CFP: 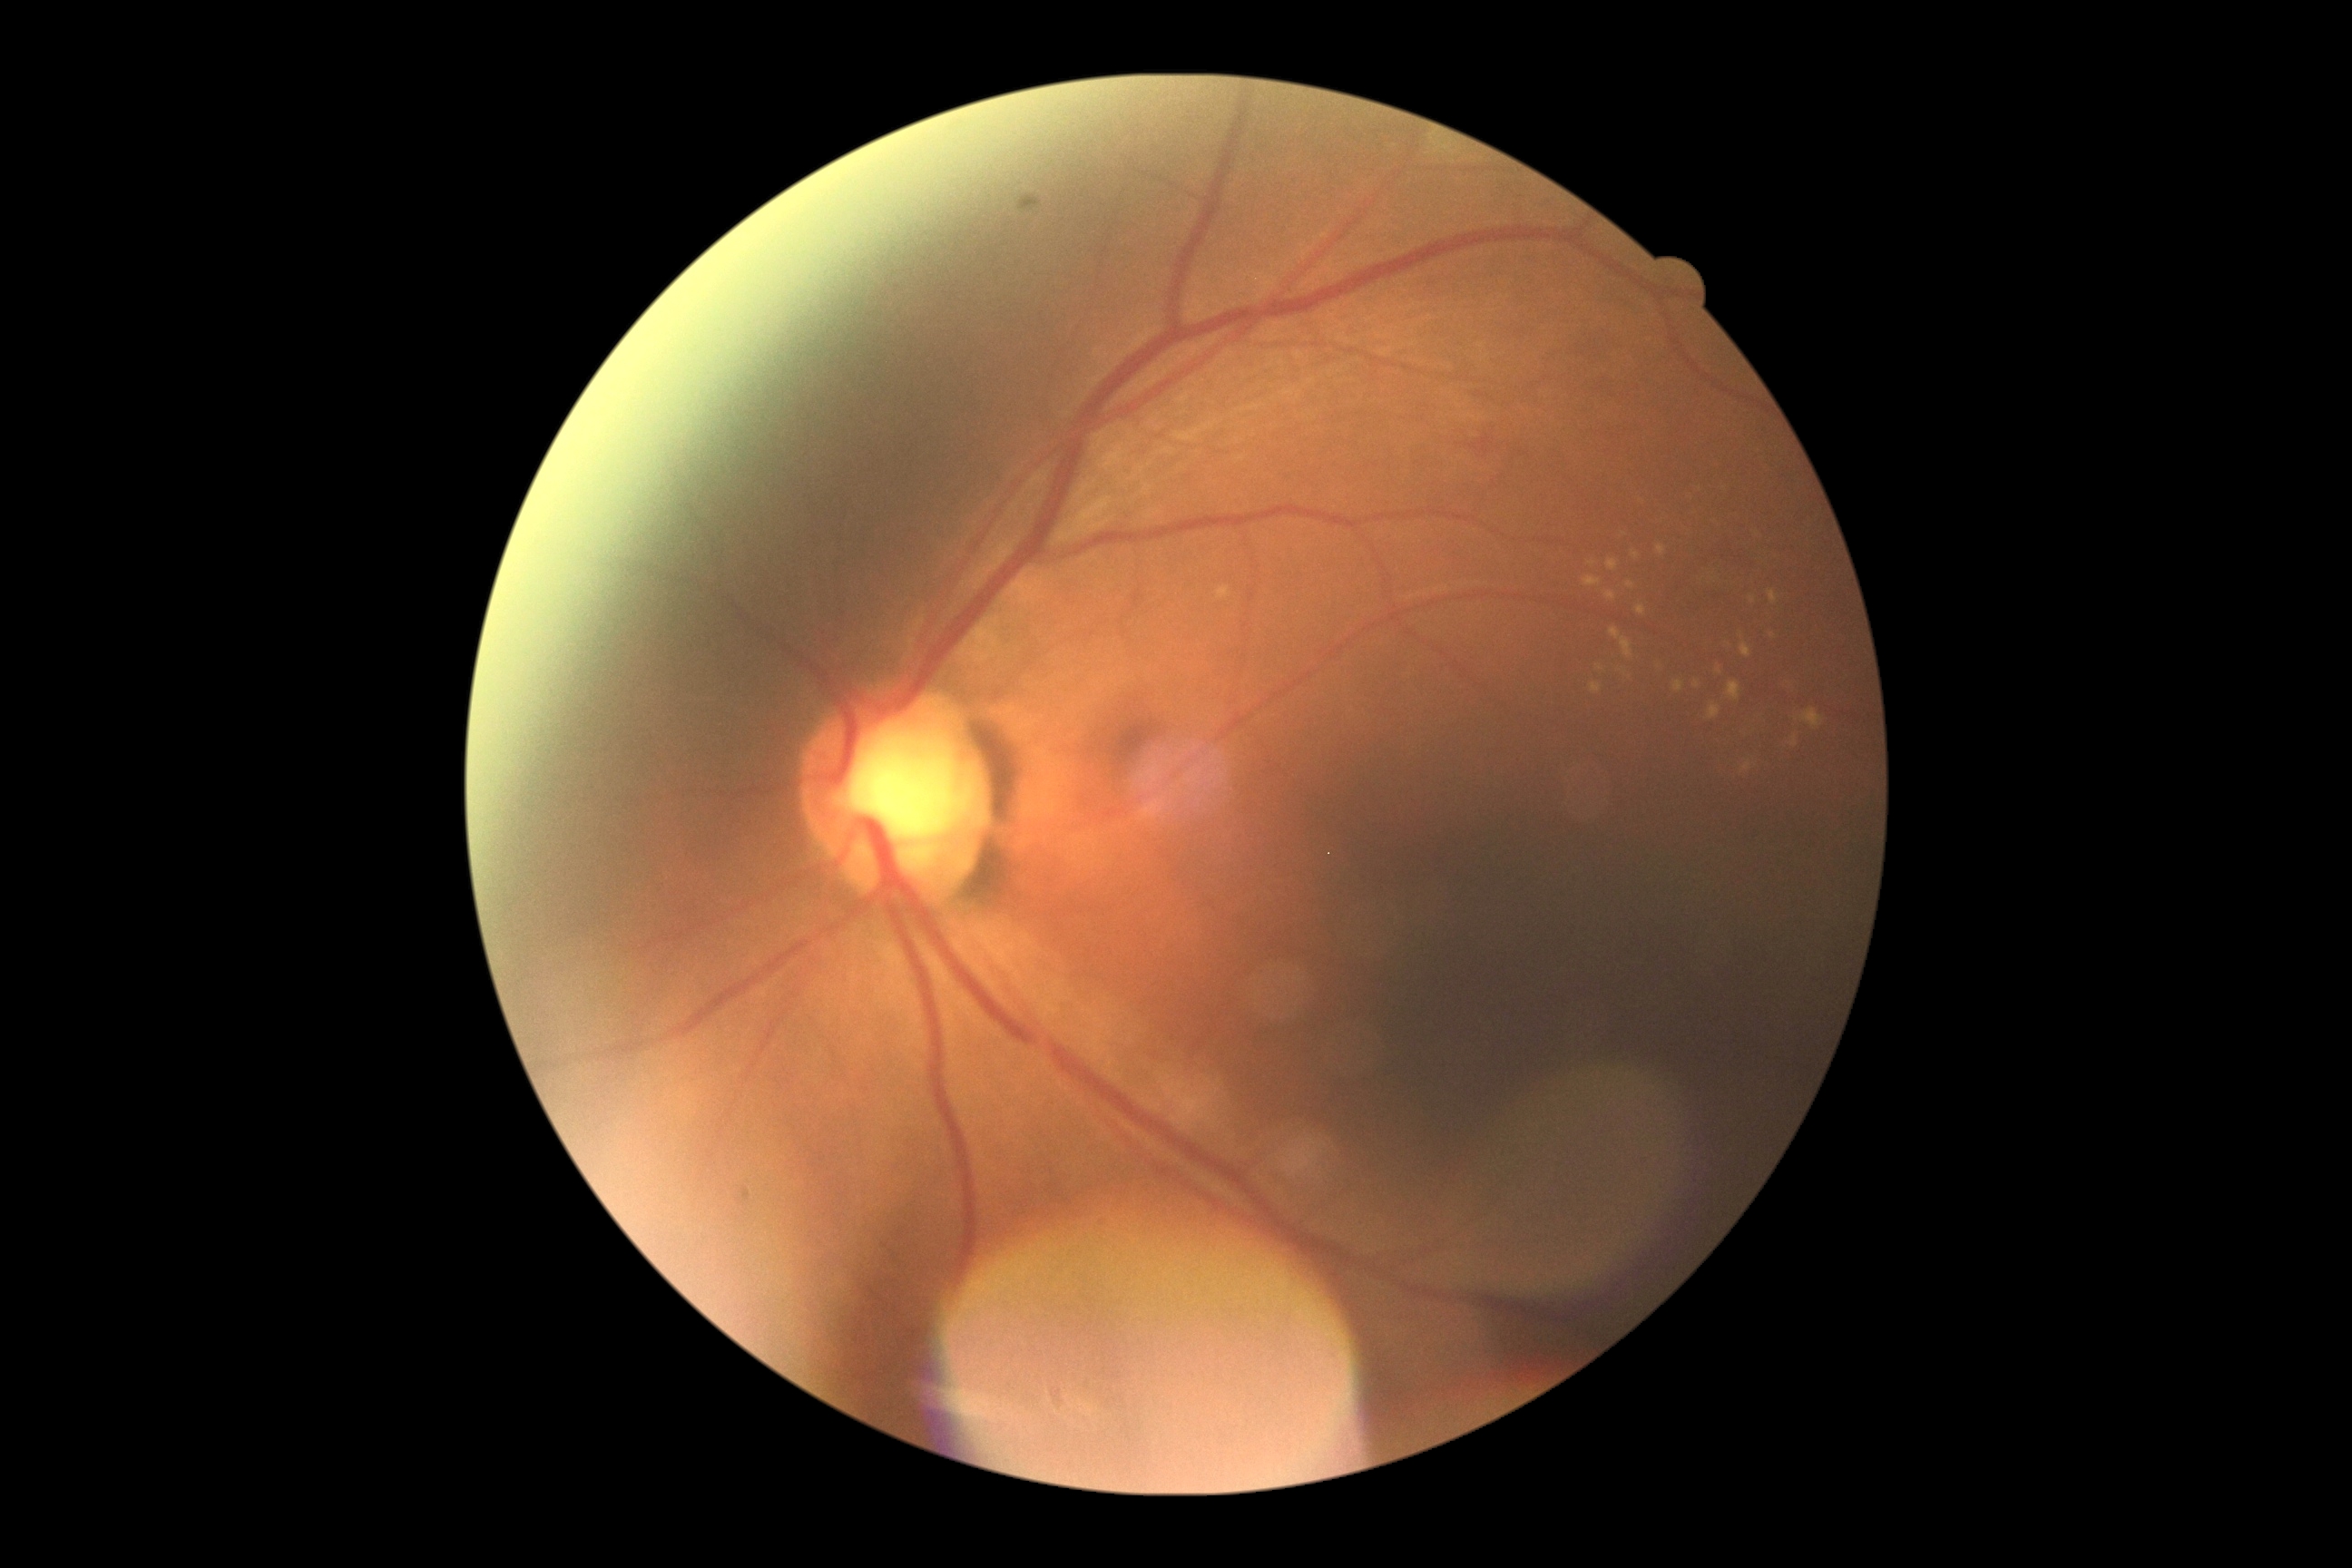 DR is grade 2.